45° field of view:
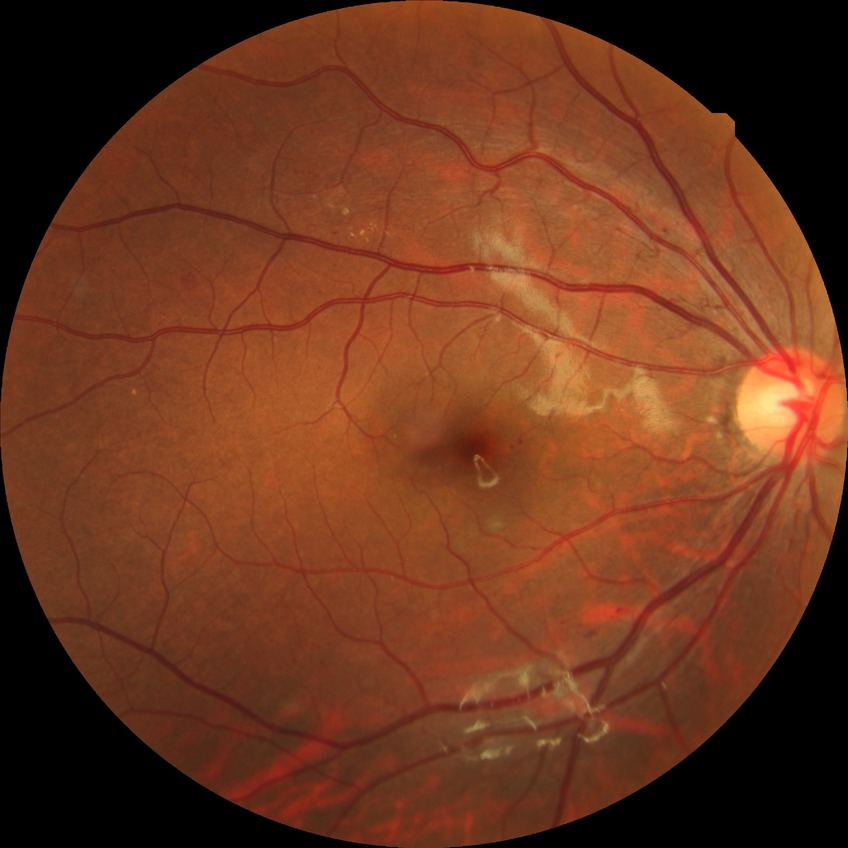 modified Davis classification: simple diabetic retinopathy, DR class: non-proliferative diabetic retinopathy.